Phoenix ICON wide-field infant fundus image; 1240x1240; 100° field of view (Phoenix ICON)
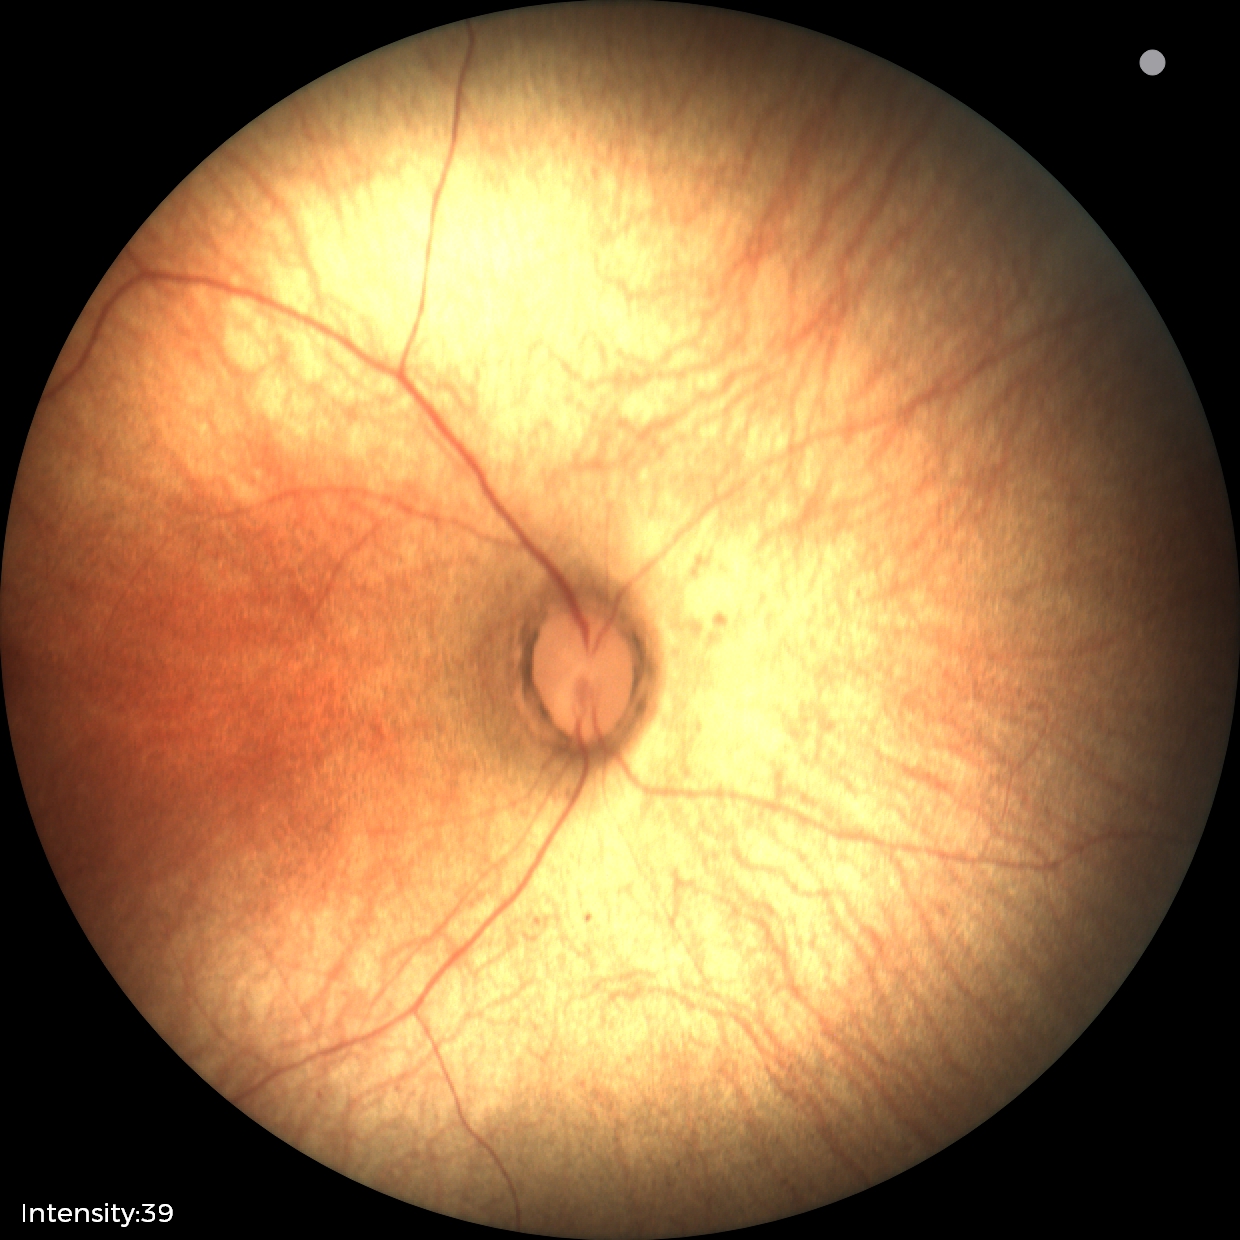
Normal screening examination.